45-degree field of view
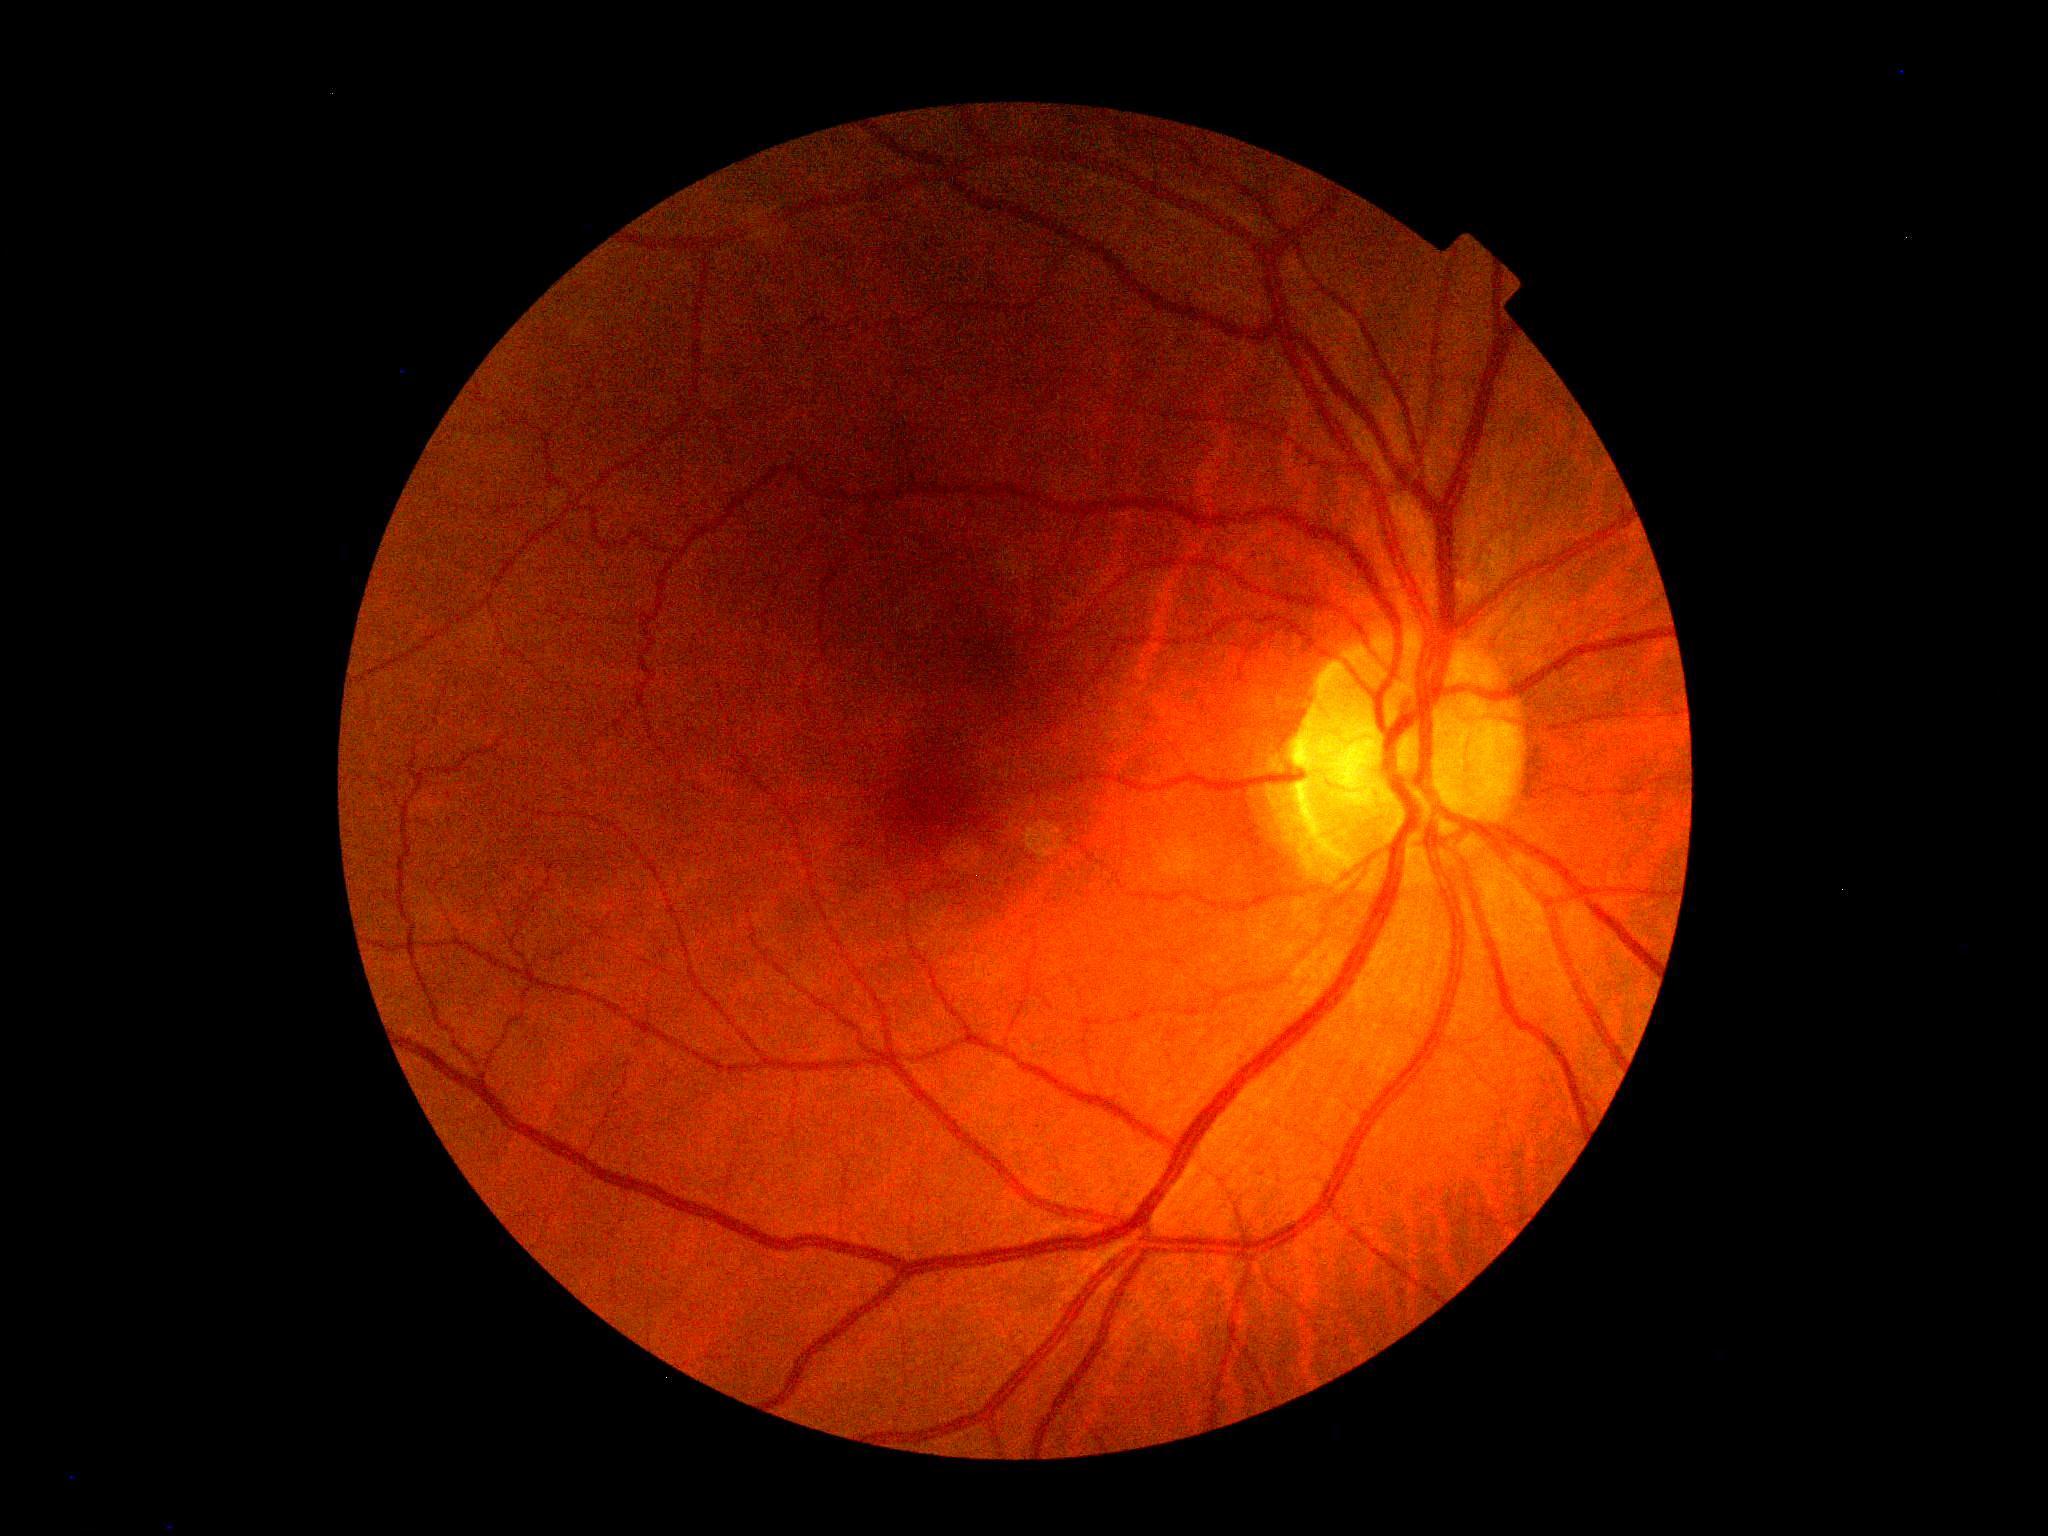 retinopathy grade=0, DR impression=no signs of DR.